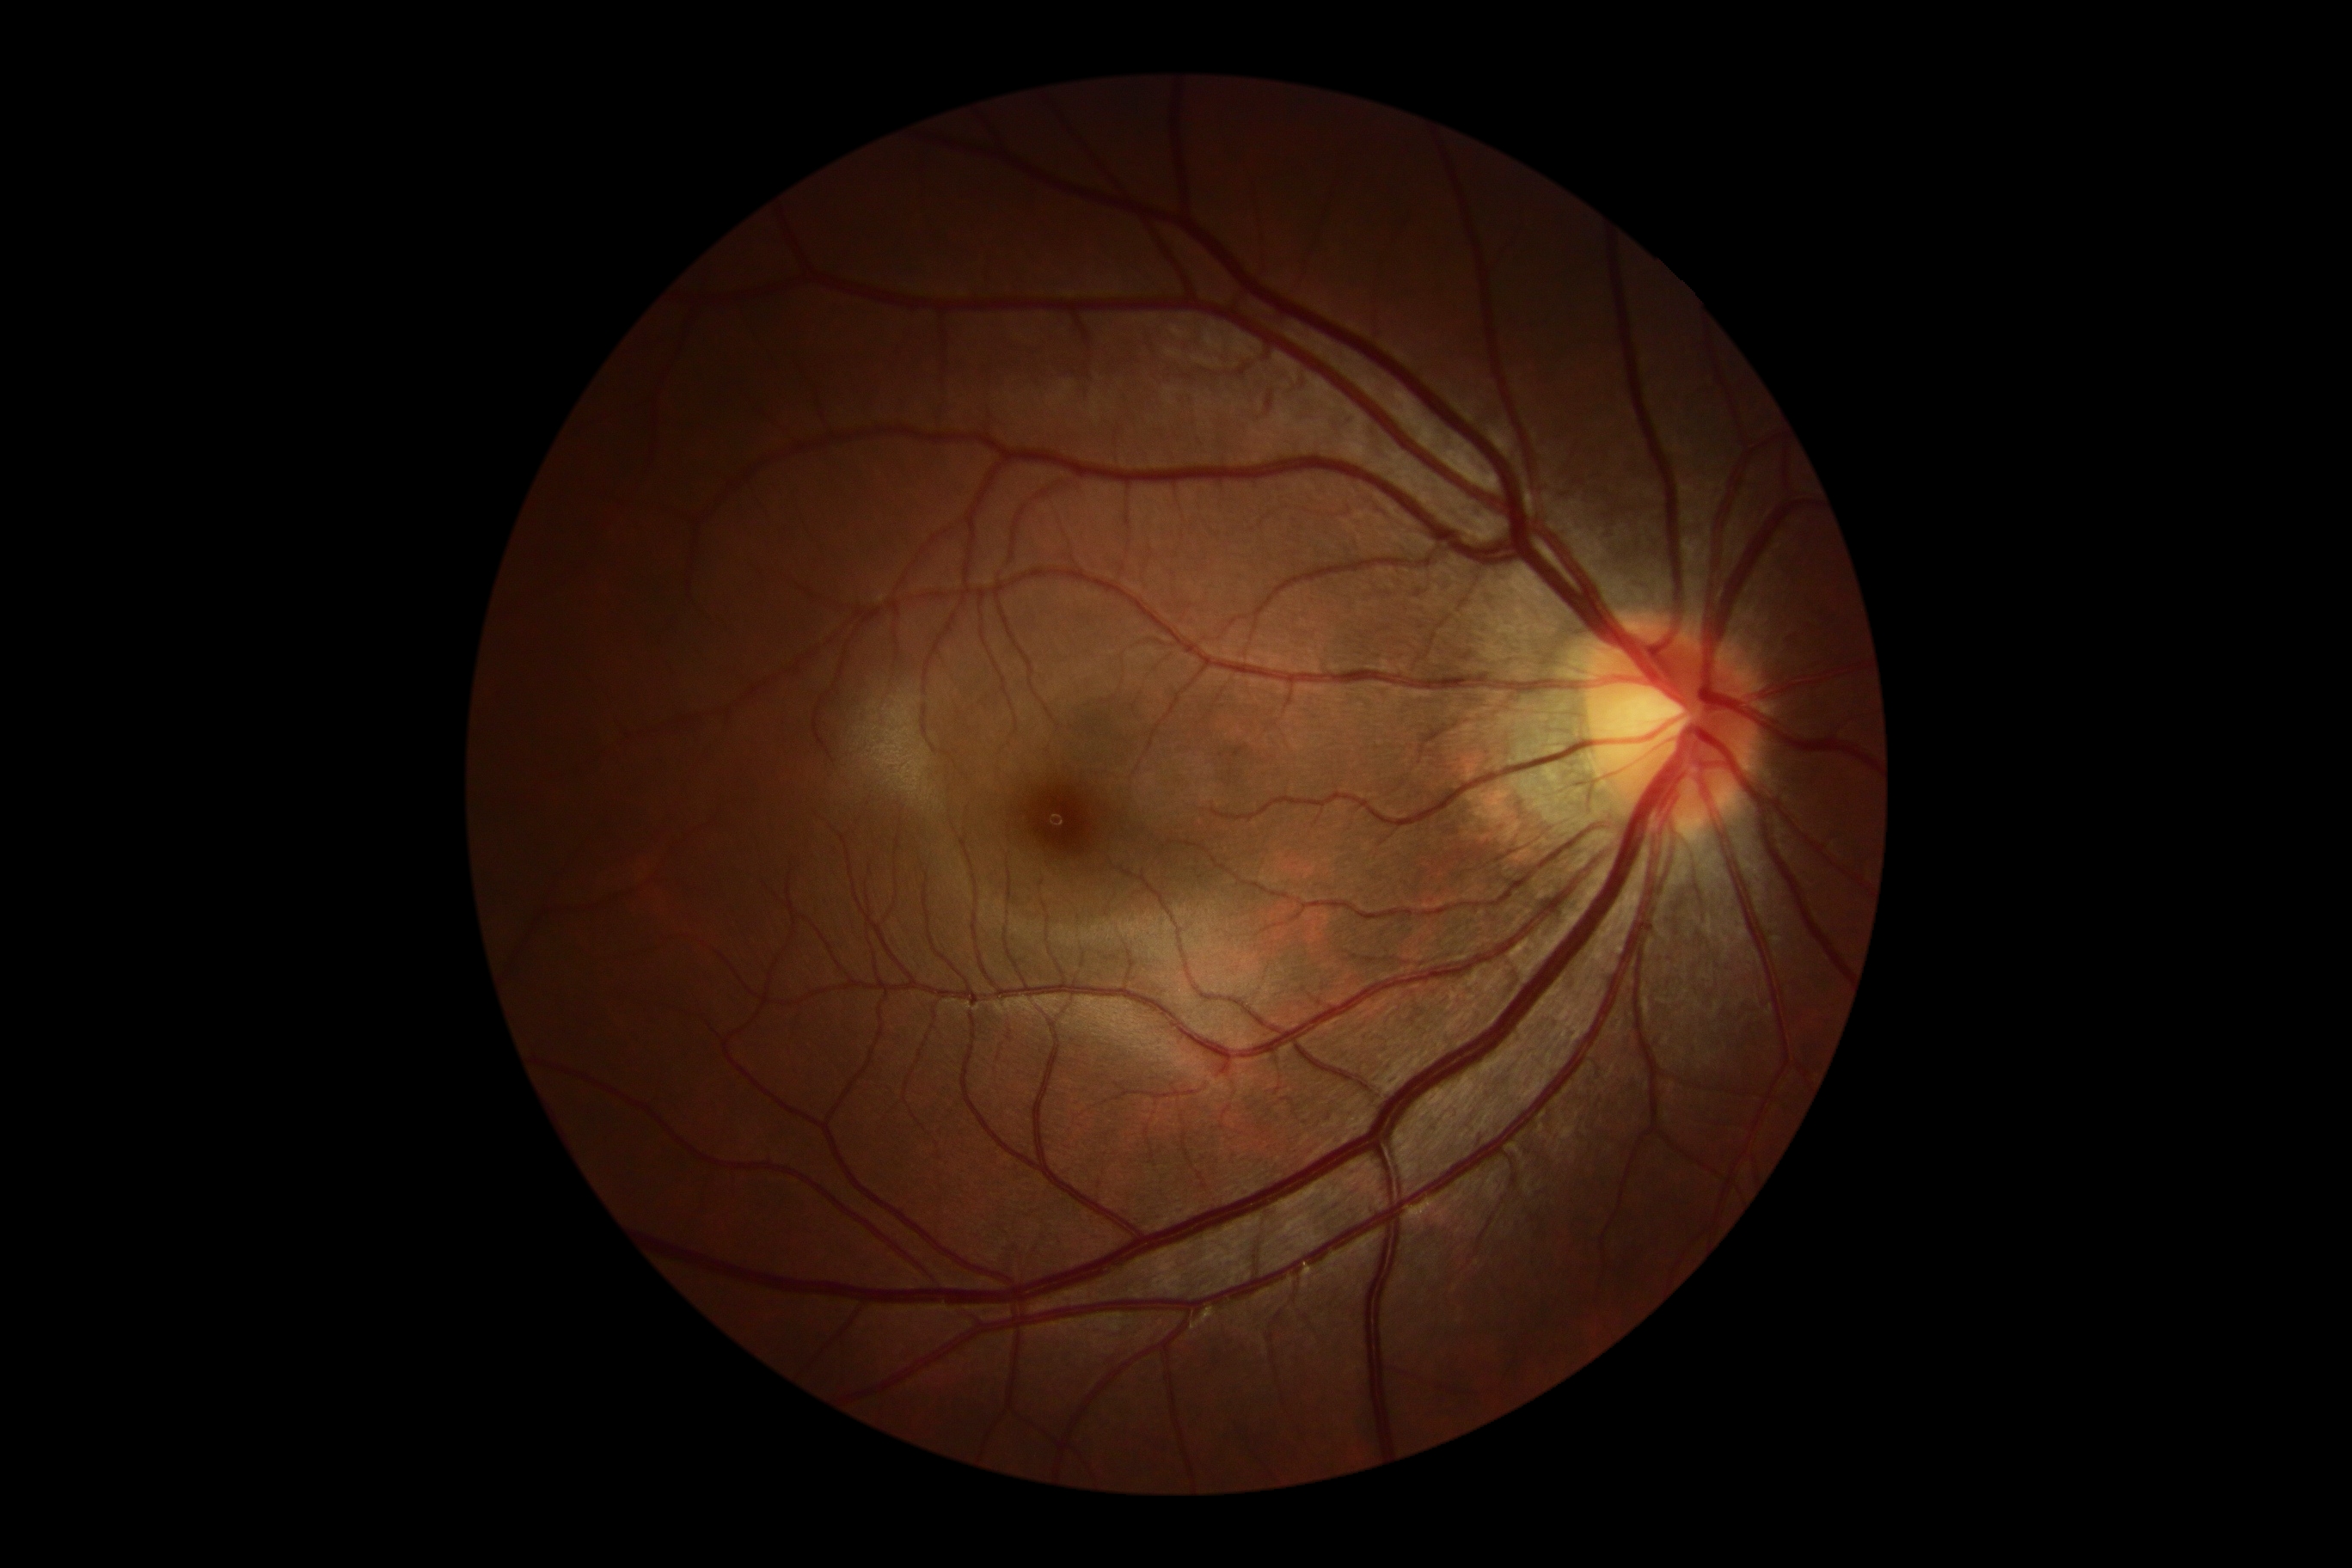

diabetic retinopathy severity: no apparent diabetic retinopathy (grade 0); DR impression: no signs of DR.